FOV: 45 degrees · camera: NIDEK AFC-230 — 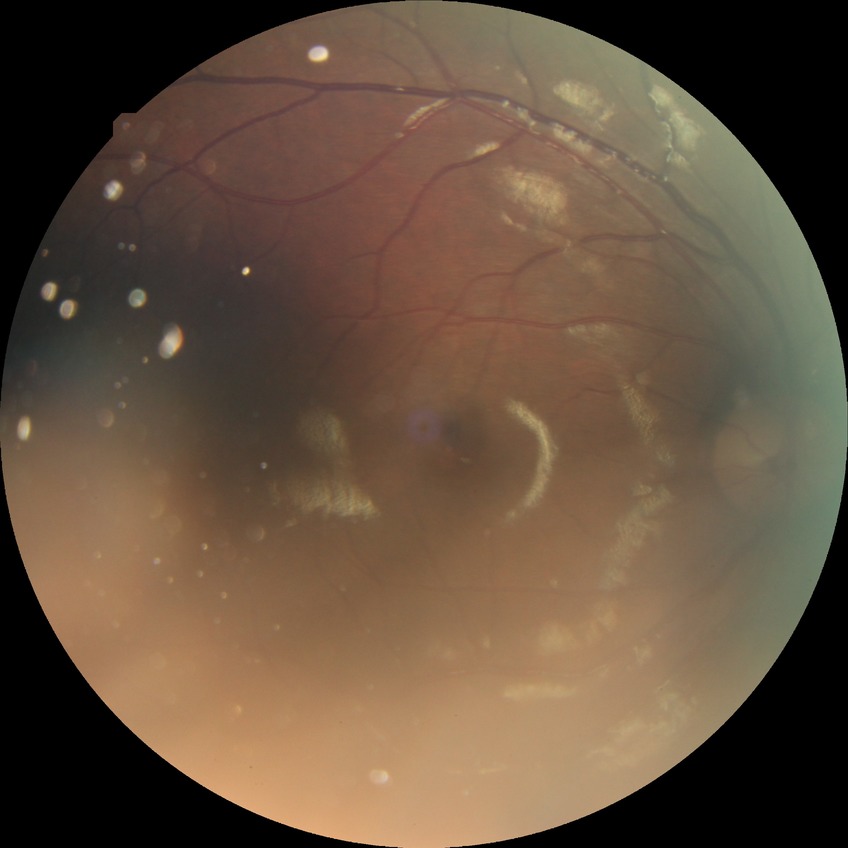

Modified Davis grading: no diabetic retinopathy.